FOV: 45 degrees
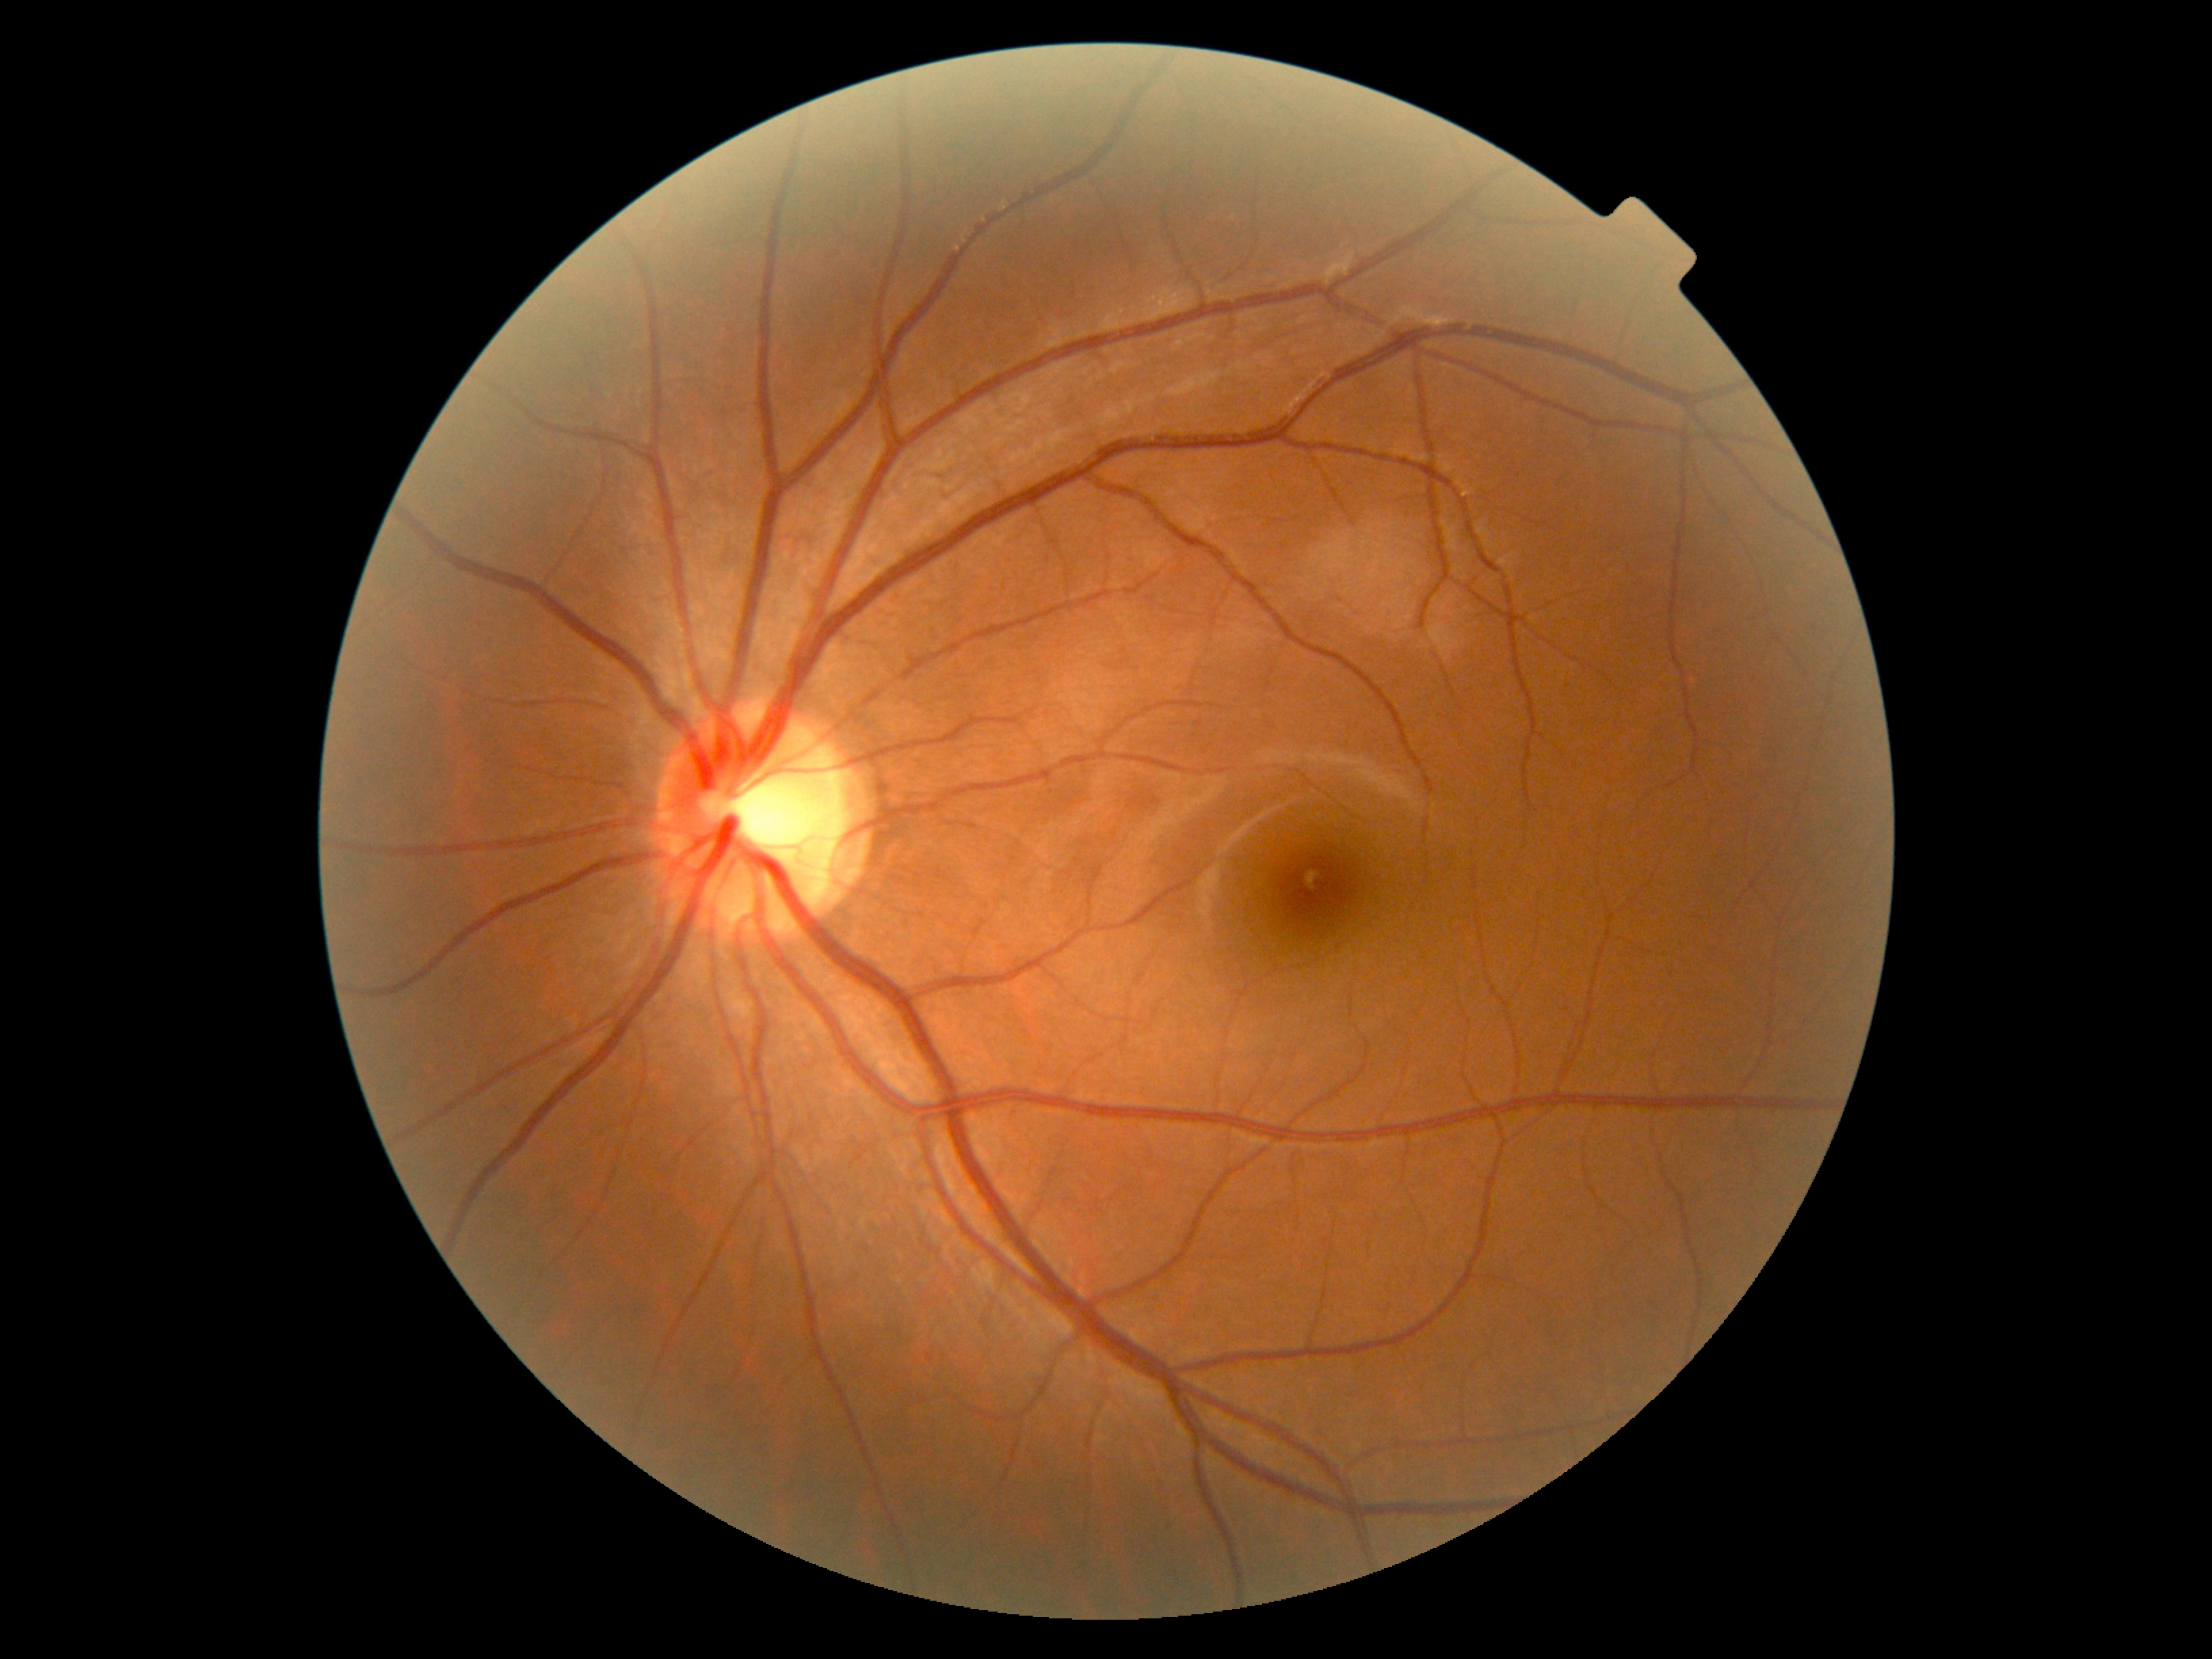 {"dr_grade": "grade 0 (no apparent retinopathy)", "dr_impression": "no apparent DR"}